45 degree fundus photograph.
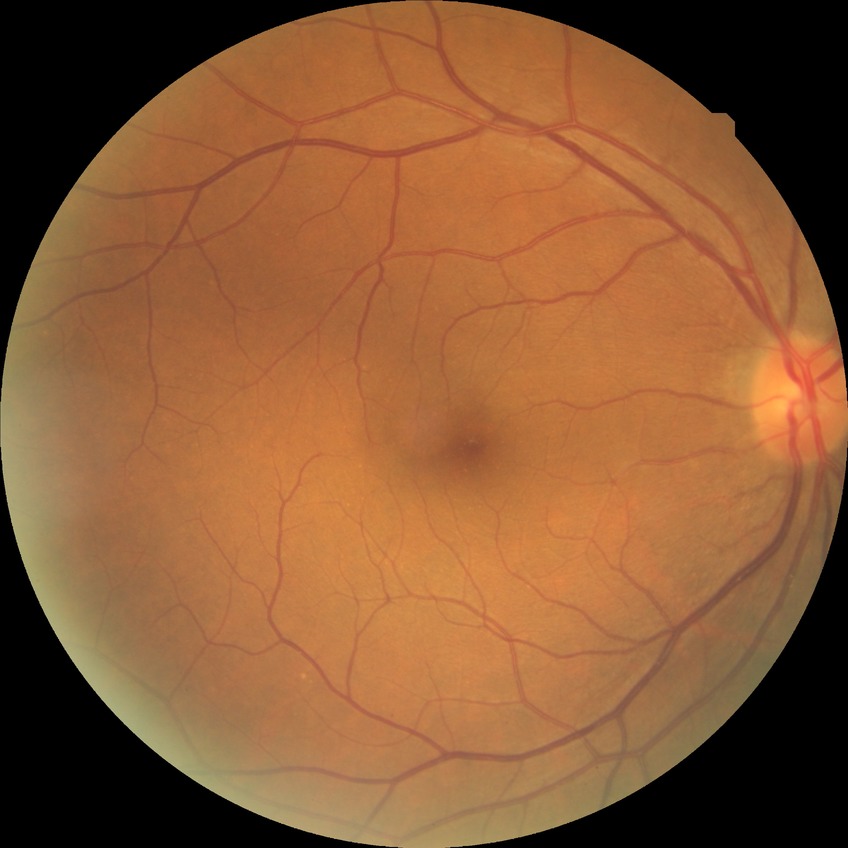

Davis grading: no diabetic retinopathy.